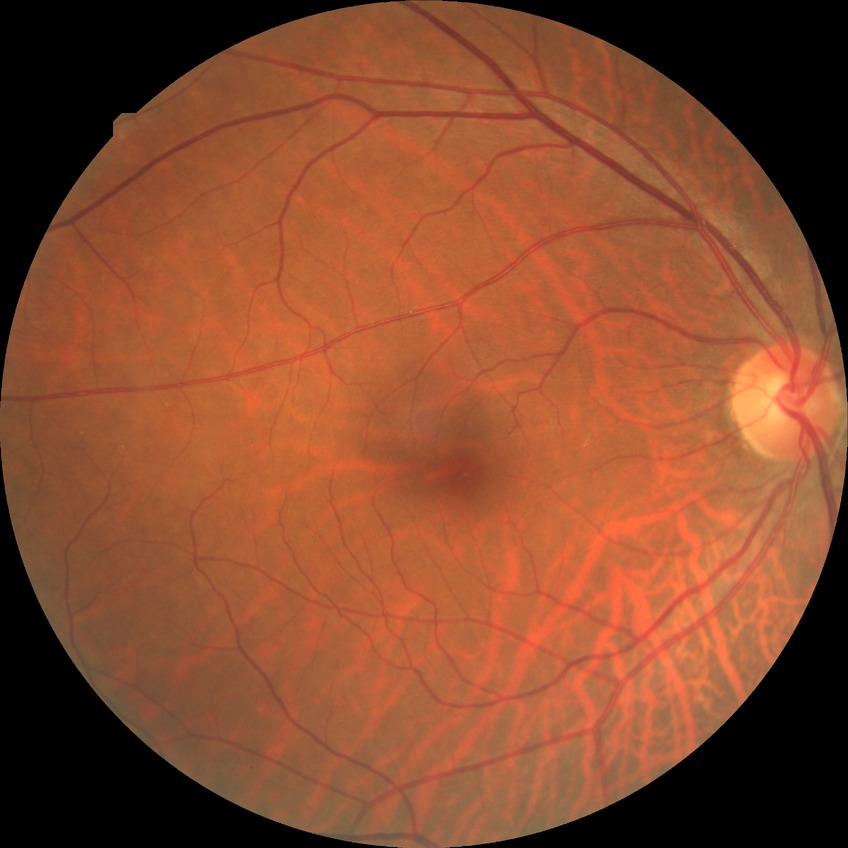 Diabetic retinopathy grade: no diabetic retinopathy.